2346x1568 · FOV: 45 degrees · color fundus image.
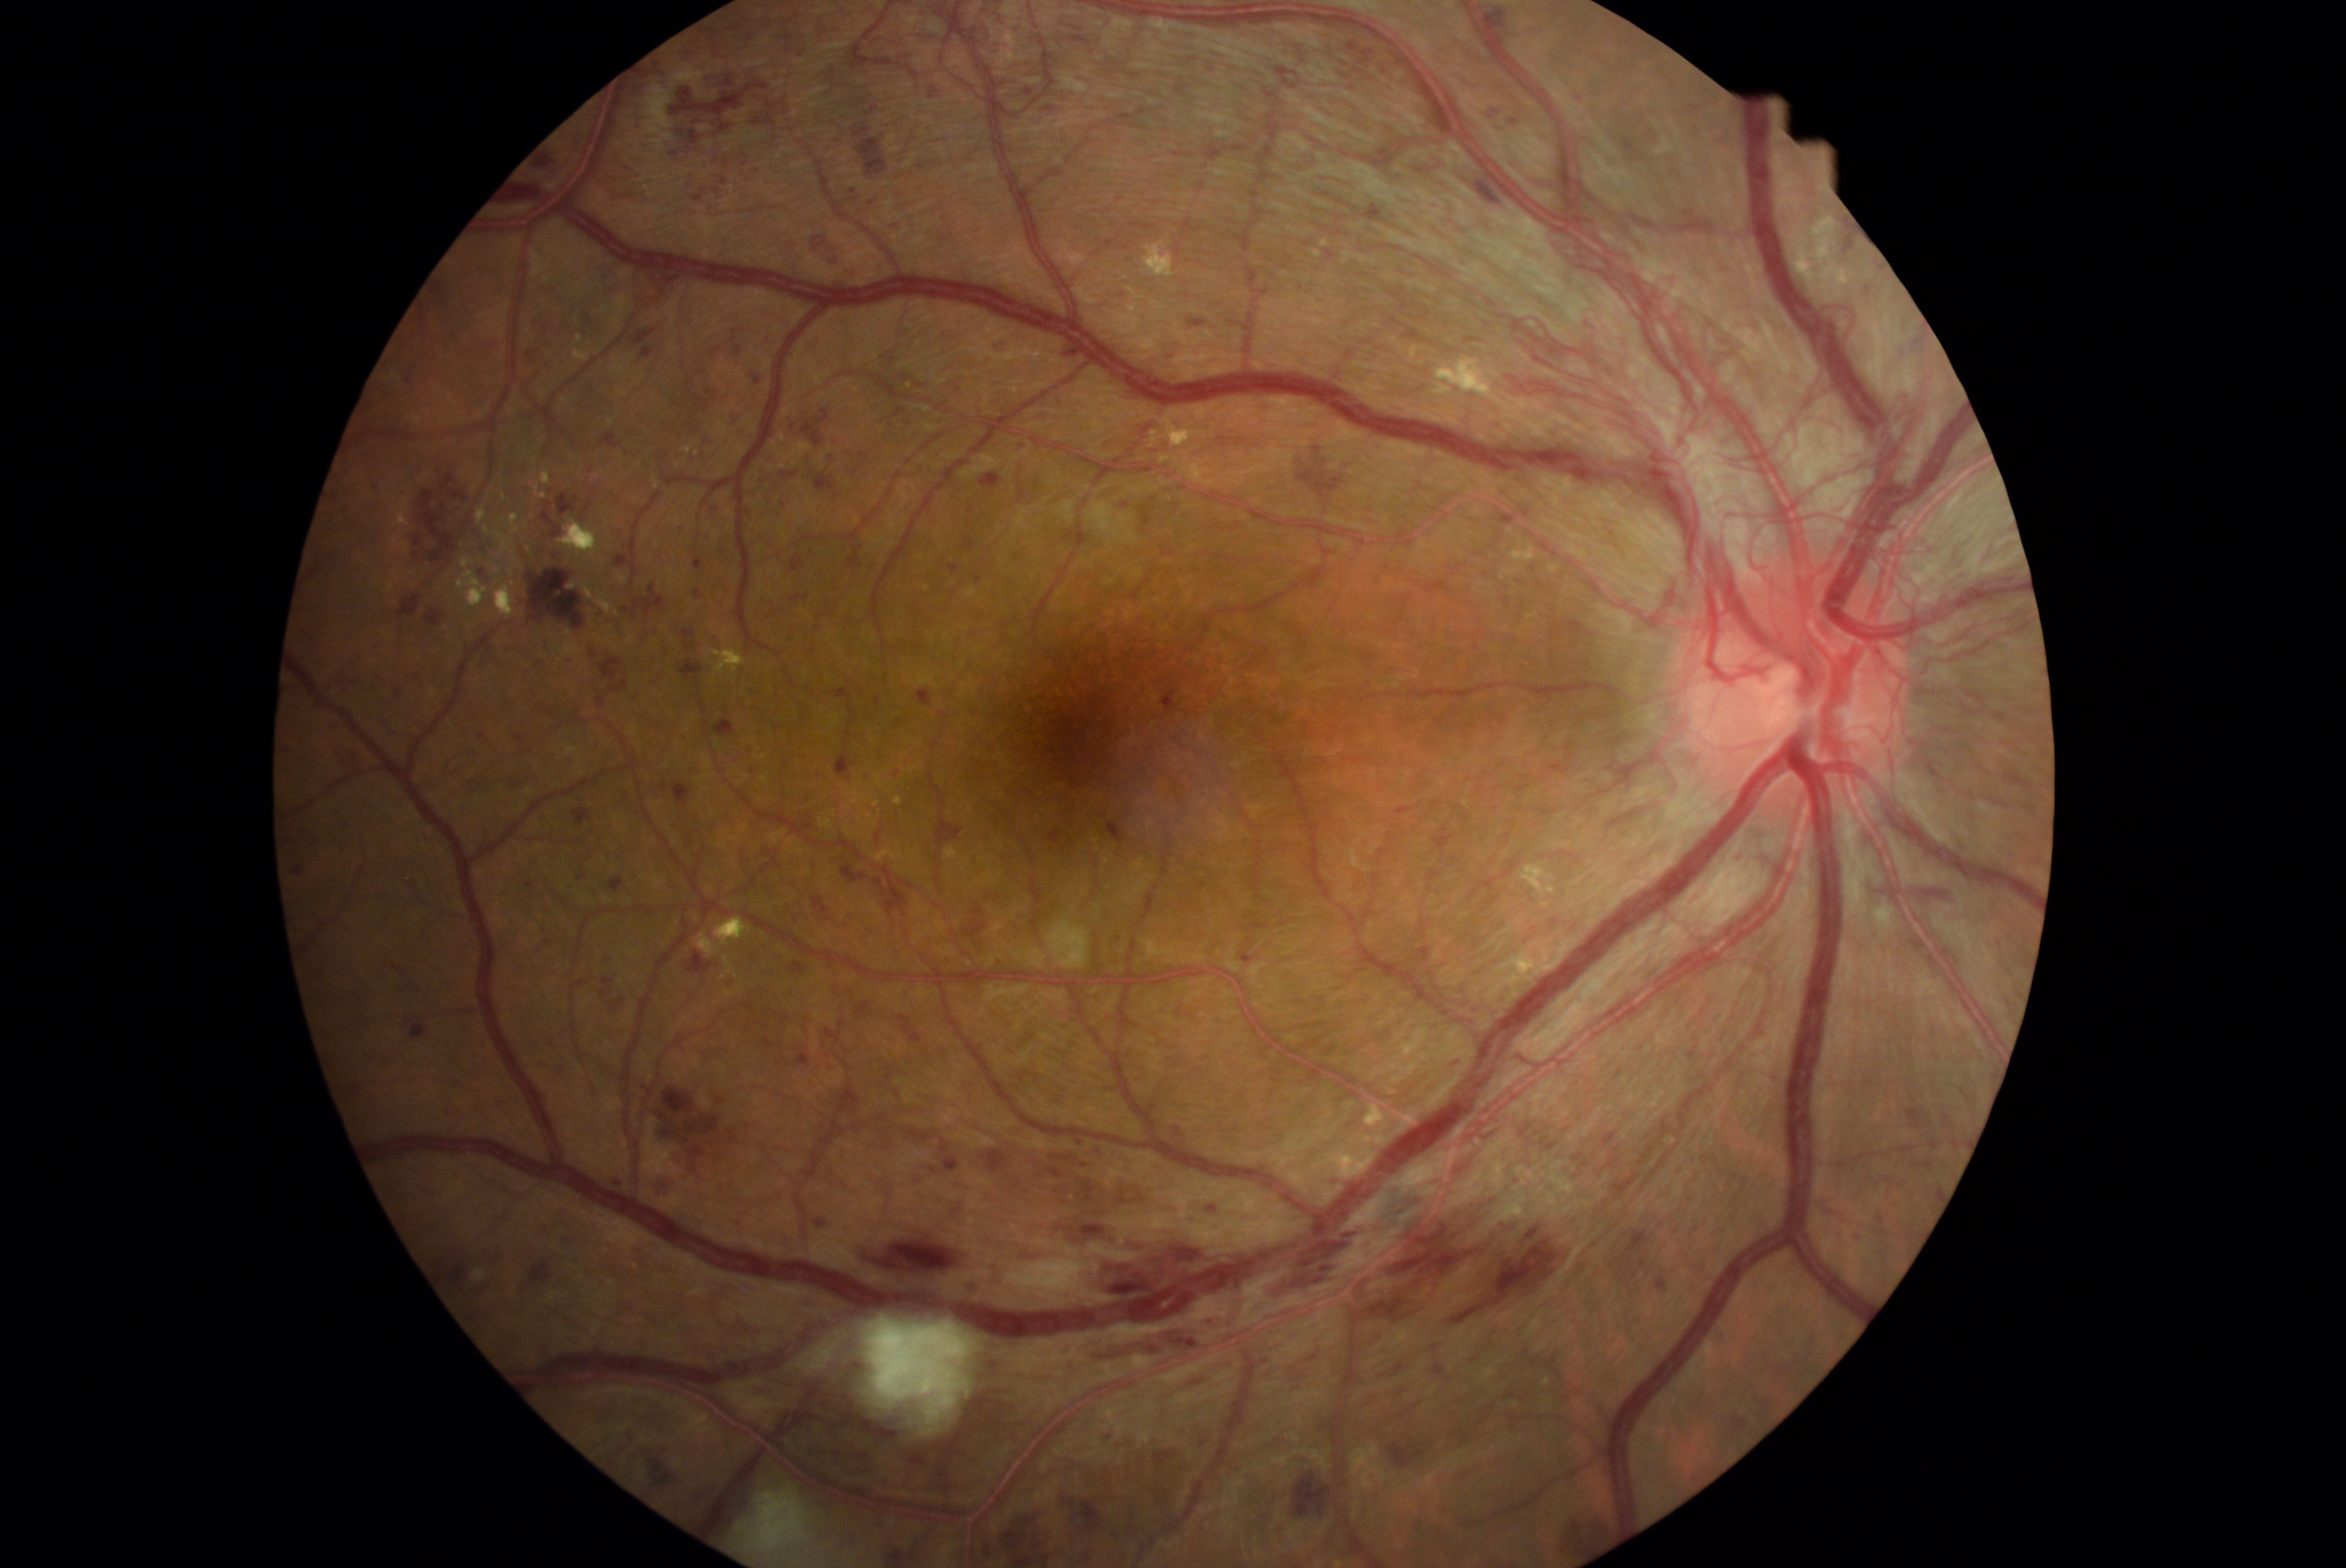

Diabetic retinopathy: proliferative diabetic retinopathy (grade 4)
Lesions identified (partial list):
hard exudates (partial): [874,800,881,808]; [1196,407,1208,421]; [1365,1106,1385,1128]; [501,492,507,501]; [1312,1139,1376,1178]; [459,557,490,608]; [653,476,659,490]; [495,581,515,617]; [1150,419,1207,449]; [1404,343,1497,397]; [509,568,514,576]; [1541,902,1550,909]; [1812,217,1837,261]; [542,471,553,485]; [724,956,738,976]; [575,349,592,361]; [399,499,410,528]; [714,918,752,946]
Smaller hard exudates around [1126,277]; [835,816]
hemorrhages (partial): [904,1453,931,1467]; [499,779,528,789]; [808,1446,874,1476]; [407,673,418,683]; [1265,1341,1280,1352]; [713,719,736,738]; [1342,1163,1578,1326]; [1572,90,1585,101]; [1155,1359,1235,1403]; [692,394,710,410]; [827,1086,863,1117]; [1961,1087,1966,1095]; [810,647,816,655]; [688,953,713,975]; [680,48,694,62]; [1658,1280,1666,1290]; [950,564,959,573]; [689,1484,719,1508]; [1730,848,1748,862]
Smaller hemorrhages around [1346,76]
soft exudates: [1047,918,1091,970]; [863,1316,979,1436]; [739,1489,810,1552]; [1873,904,1898,937]
microaneurysms: none identified